Pediatric wide-field fundus photograph; 640x480: 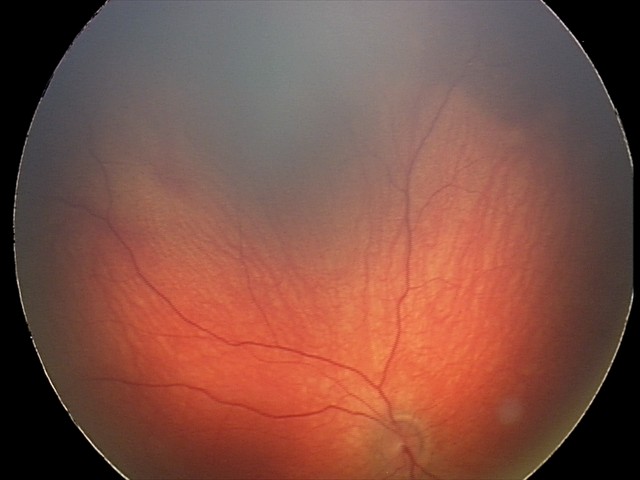

Assessment: retinal hemorrhages.